Acquired with a NIDEK AFC-230. No pharmacologic dilation.
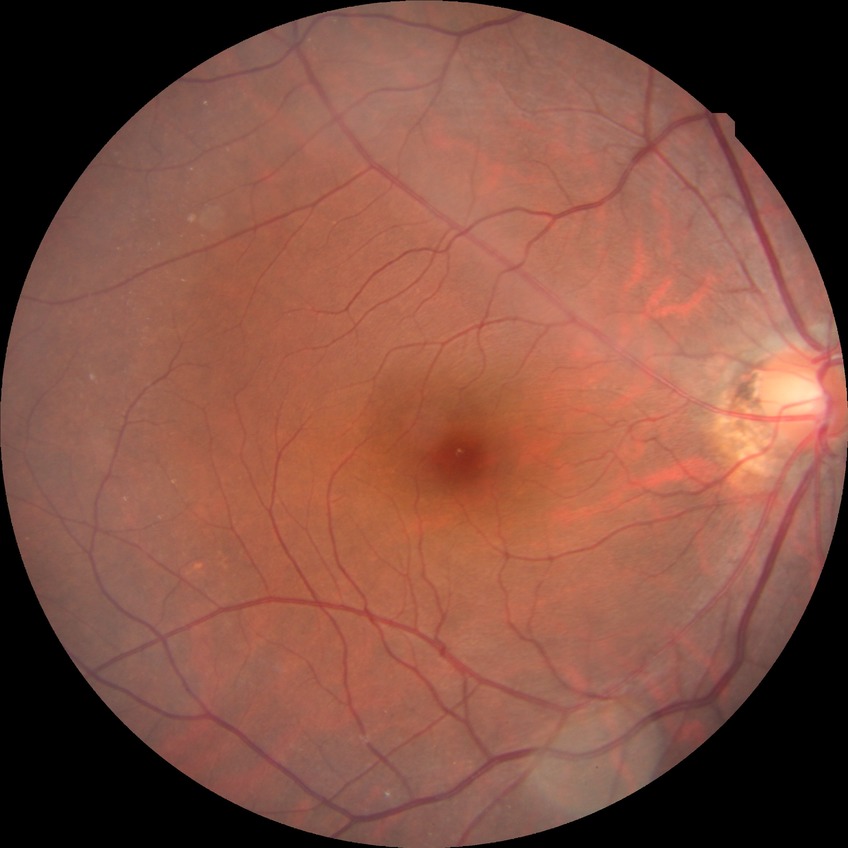

No DR findings.
Davis DR grade: NDR.